Image size 848x848. Acquired with a NIDEK AFC-230:
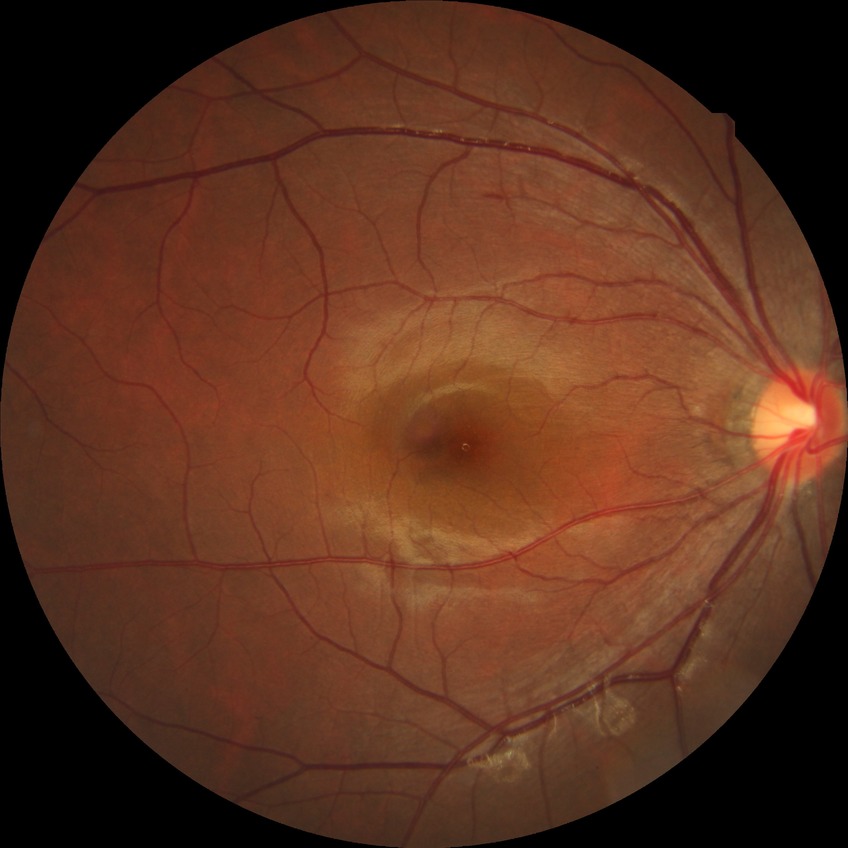 retinopathy grade=no diabetic retinopathy.